Graded on the modified Davis scale: 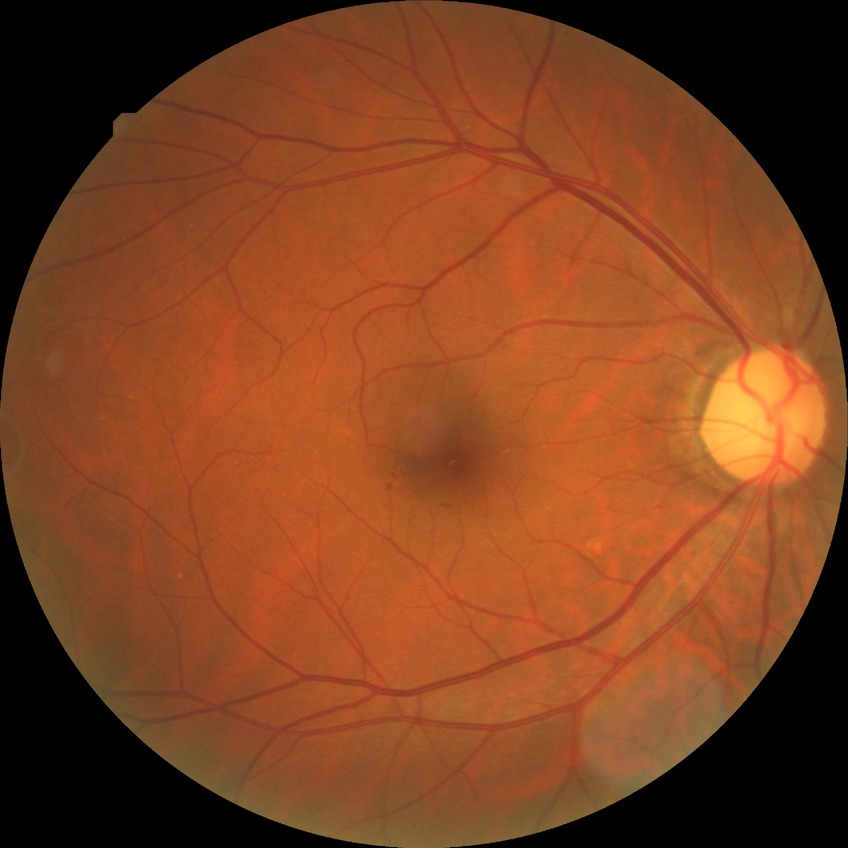

Davis DR grade is SDR. Disease class: non-proliferative diabetic retinopathy.